Color fundus photograph; 2048x1536:
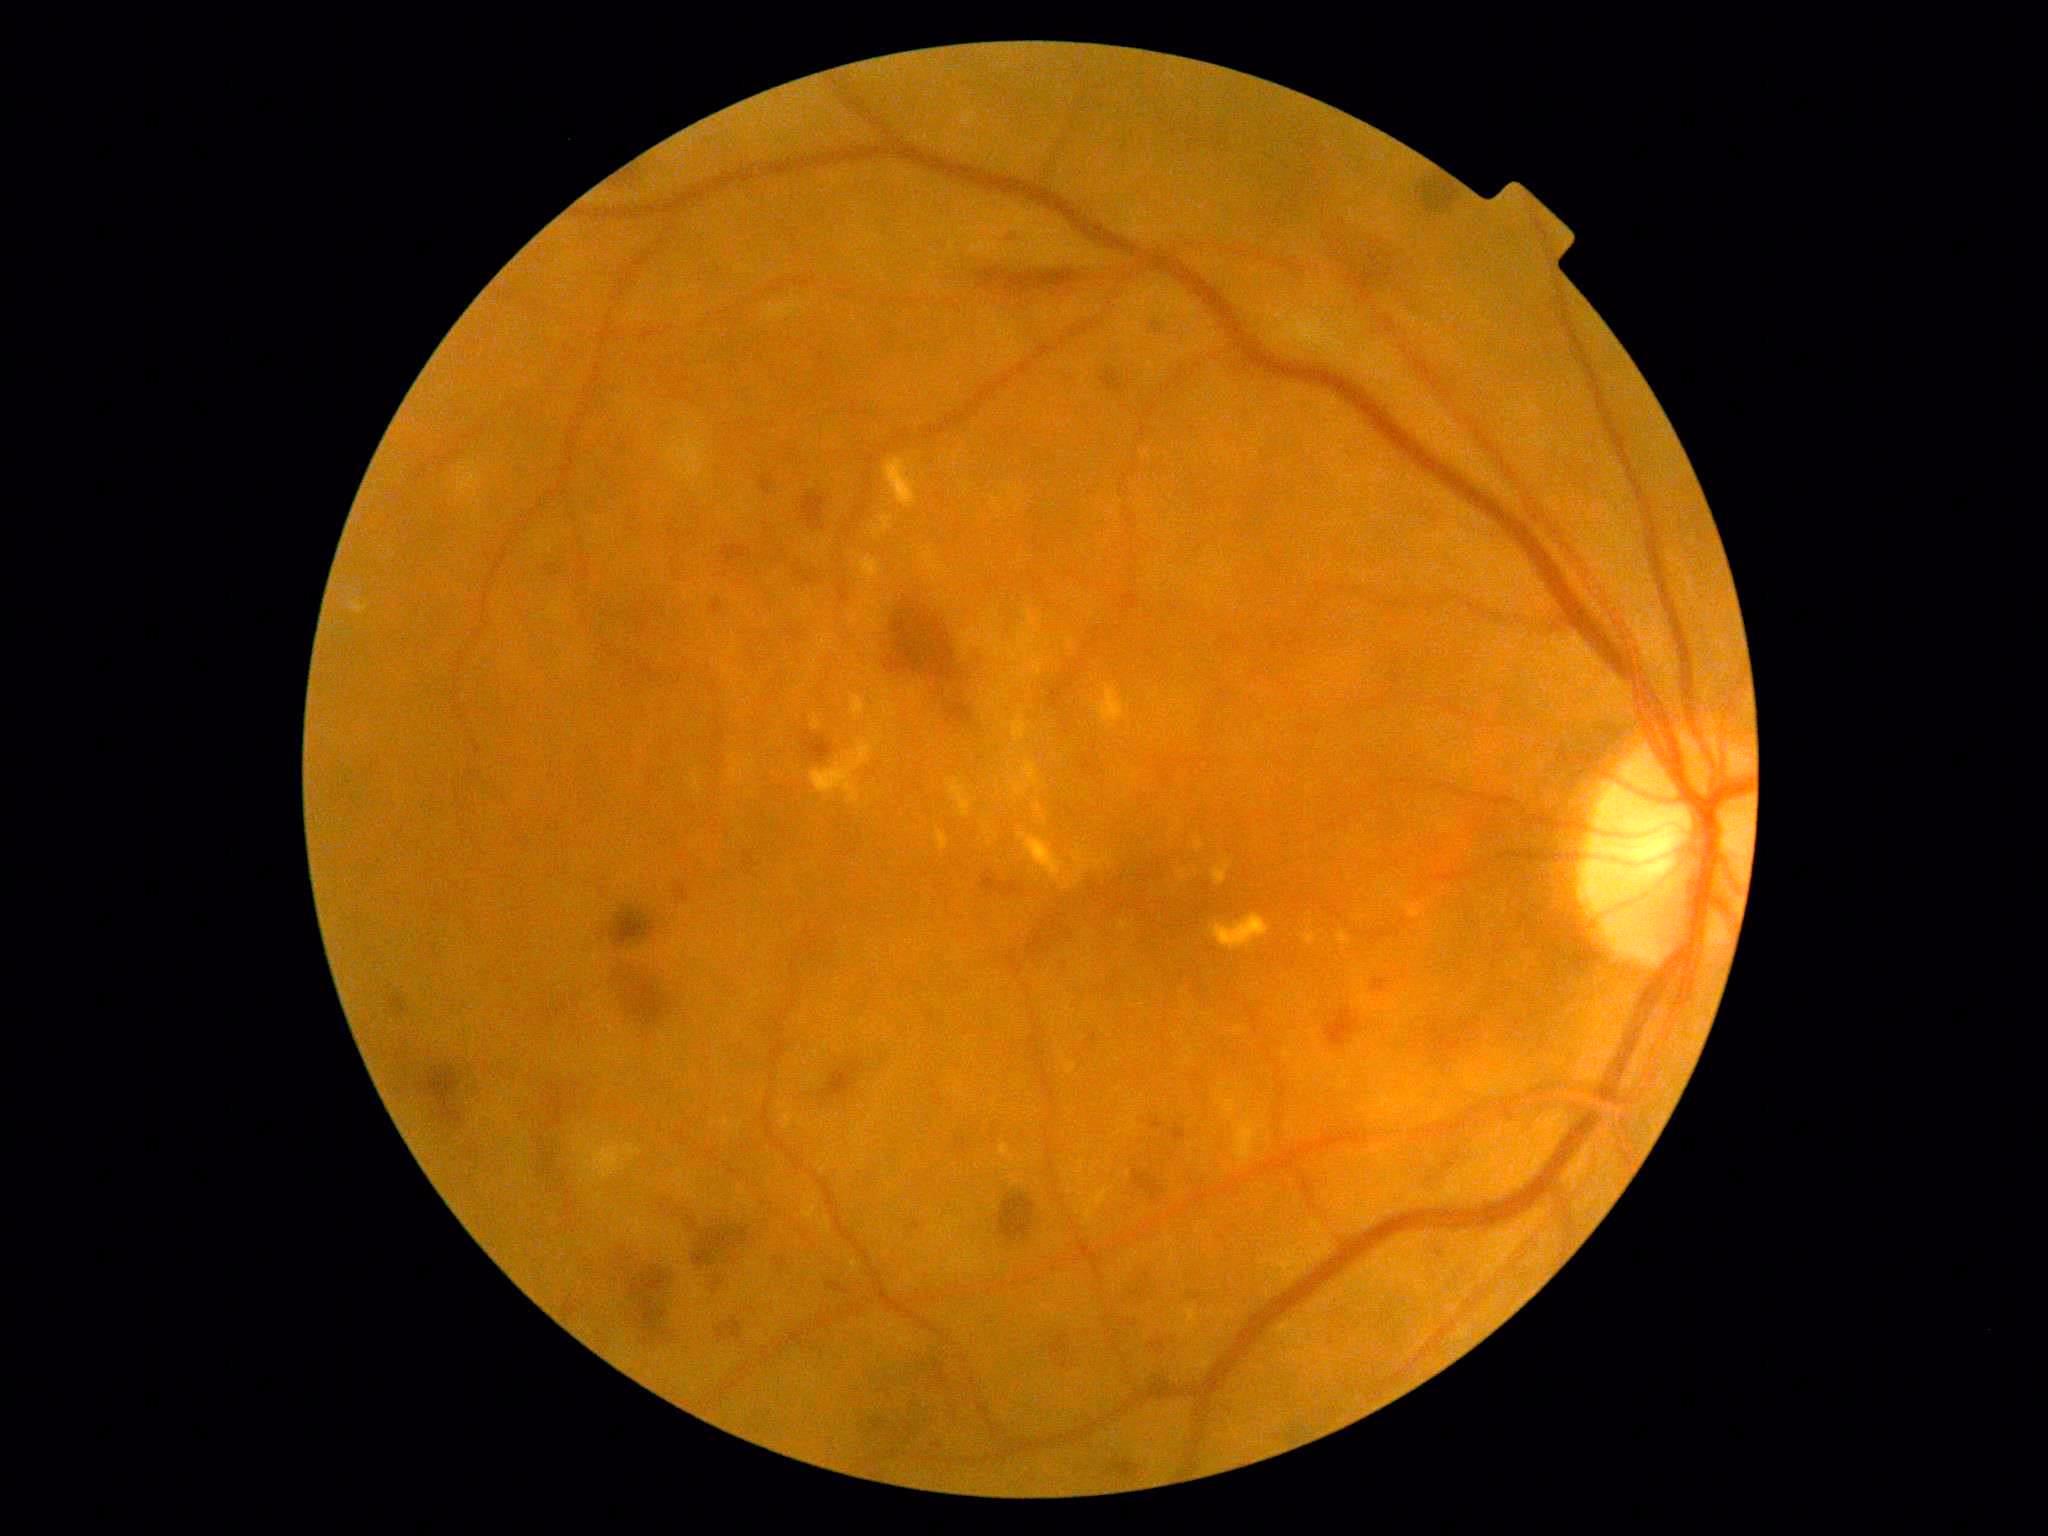 DR stage: grade 2.